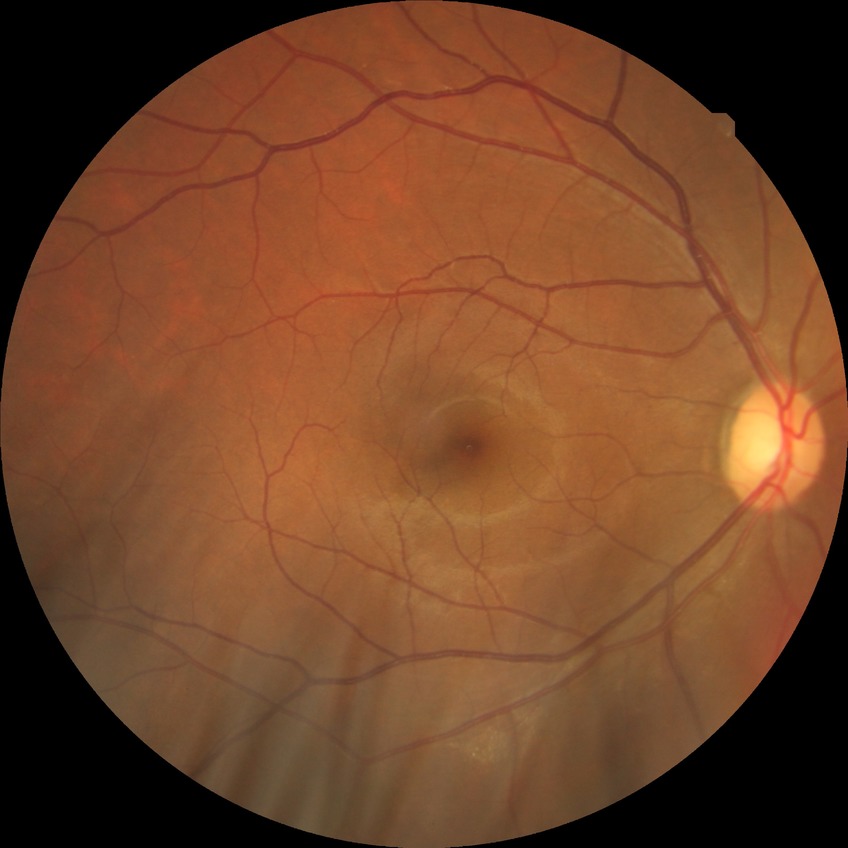

DR stage: NDR.
No DR findings.